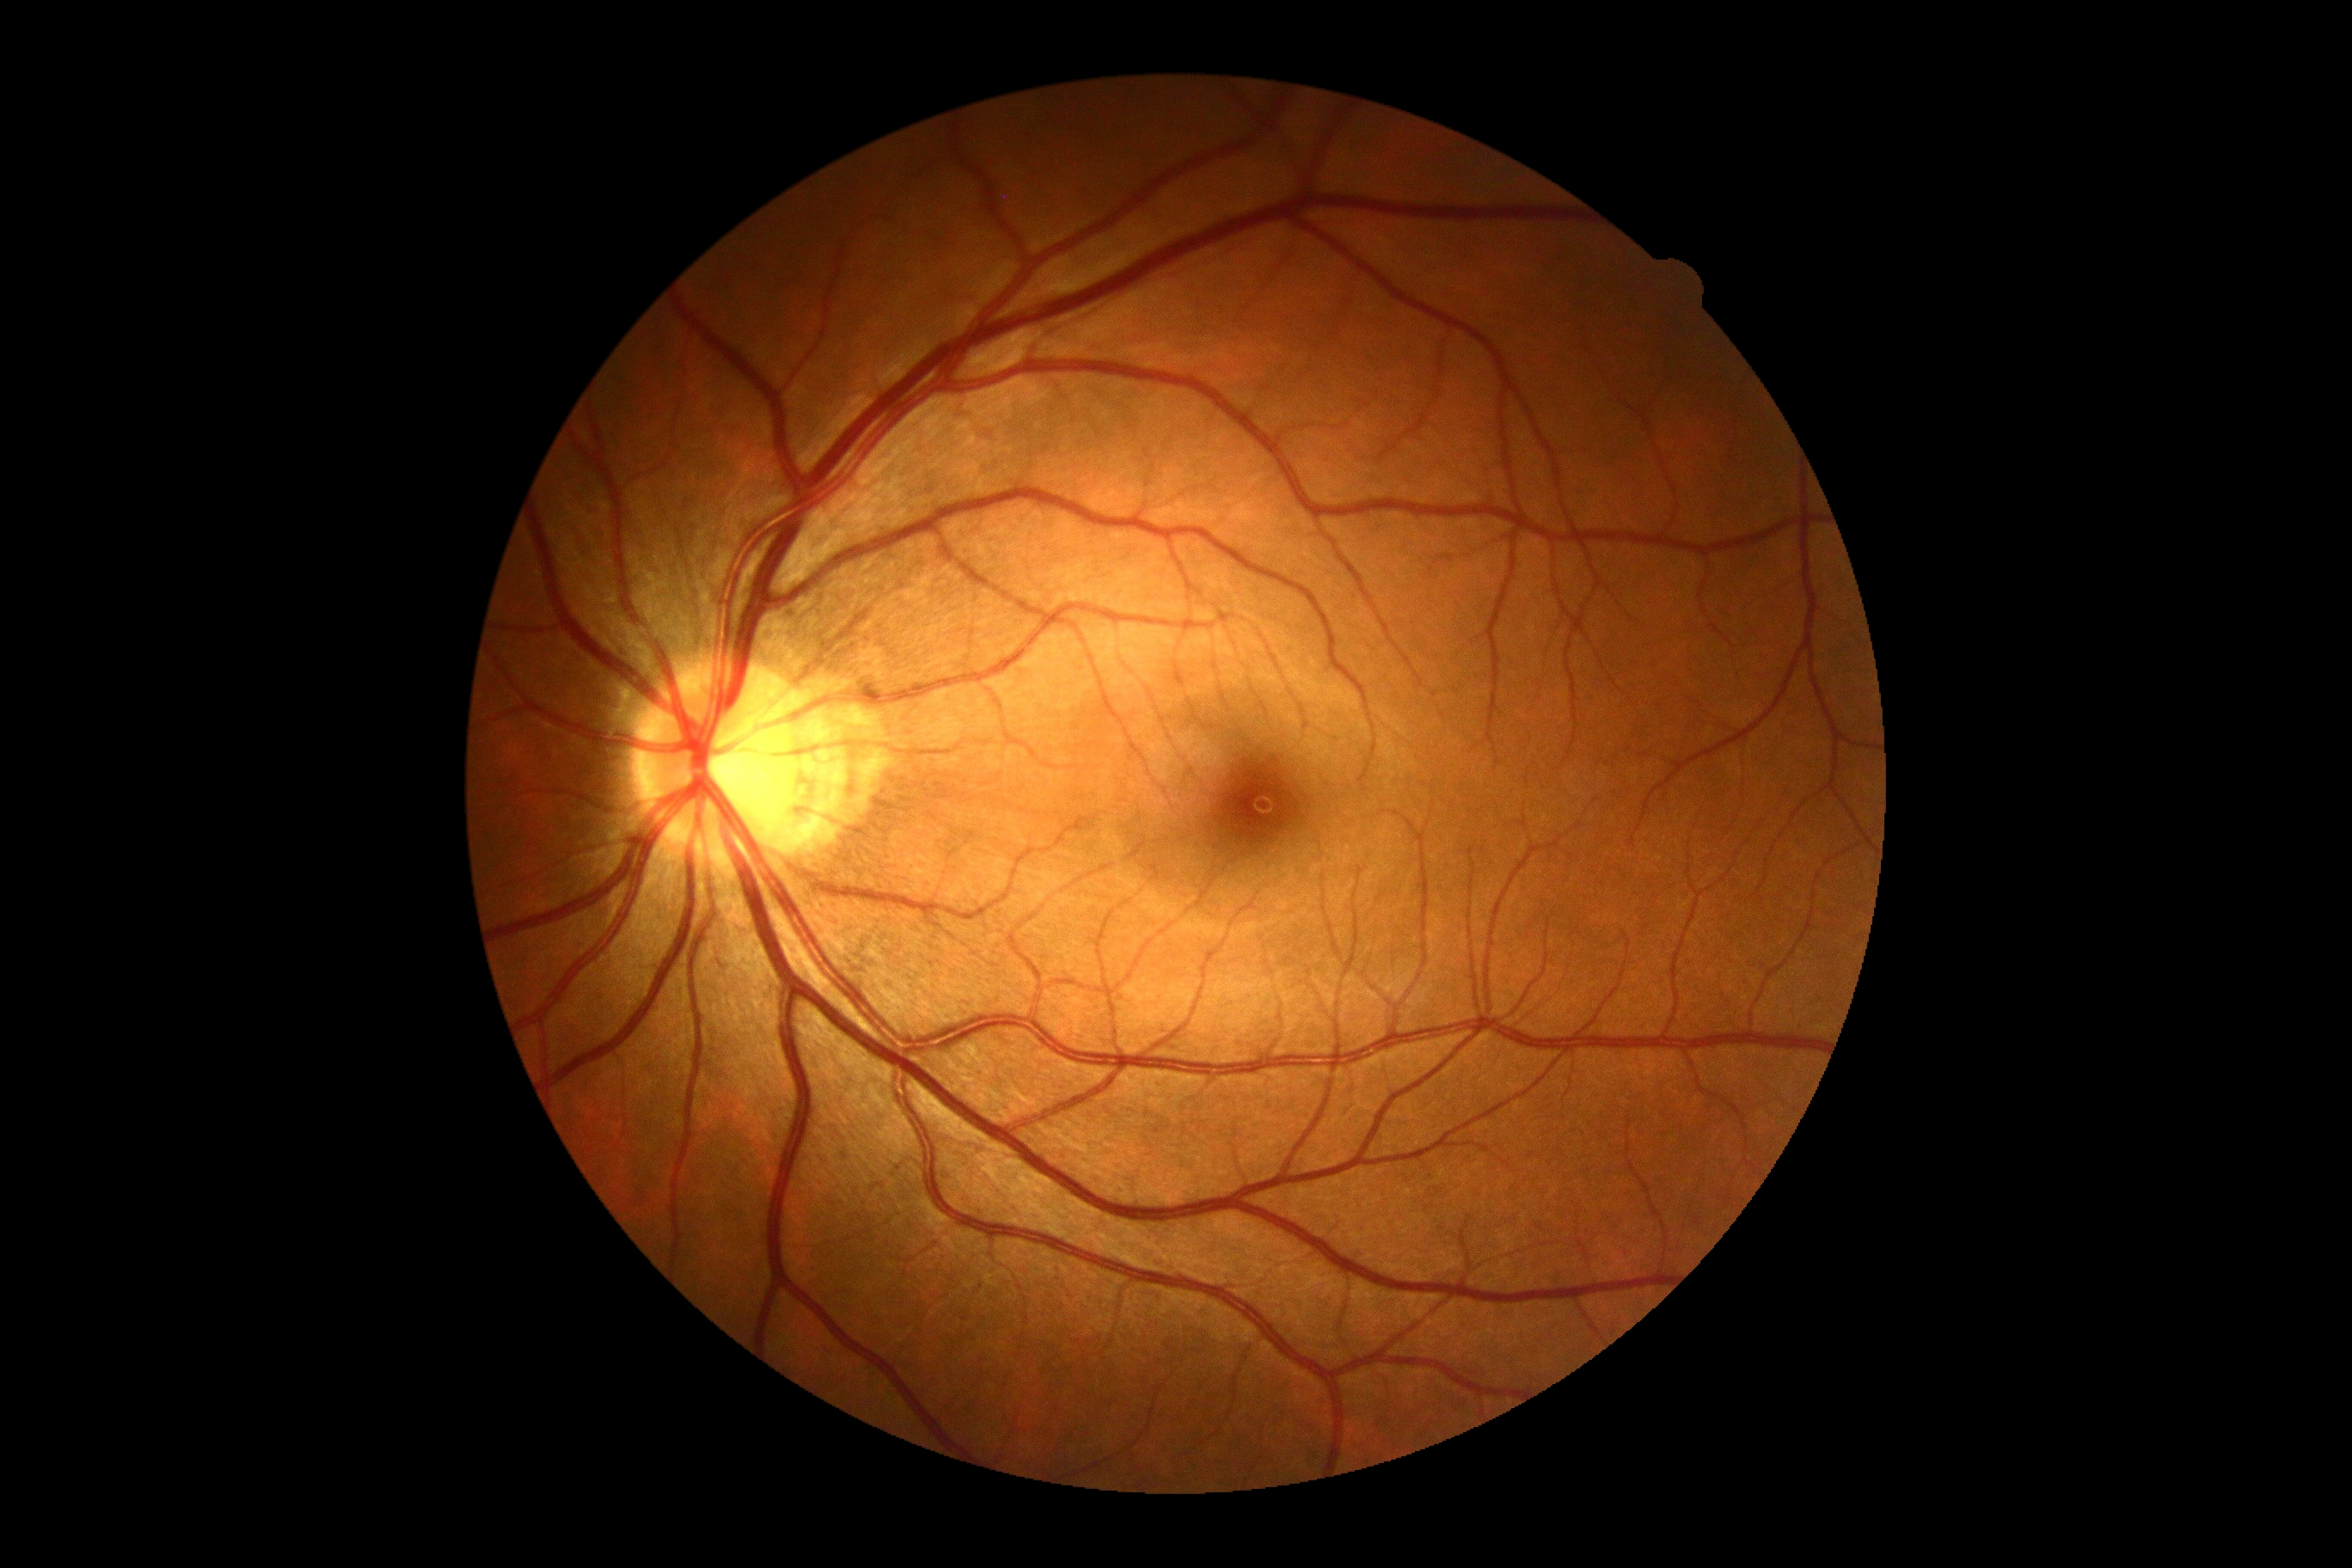

DR grade: no apparent diabetic retinopathy (0), DR impression: negative for DR.